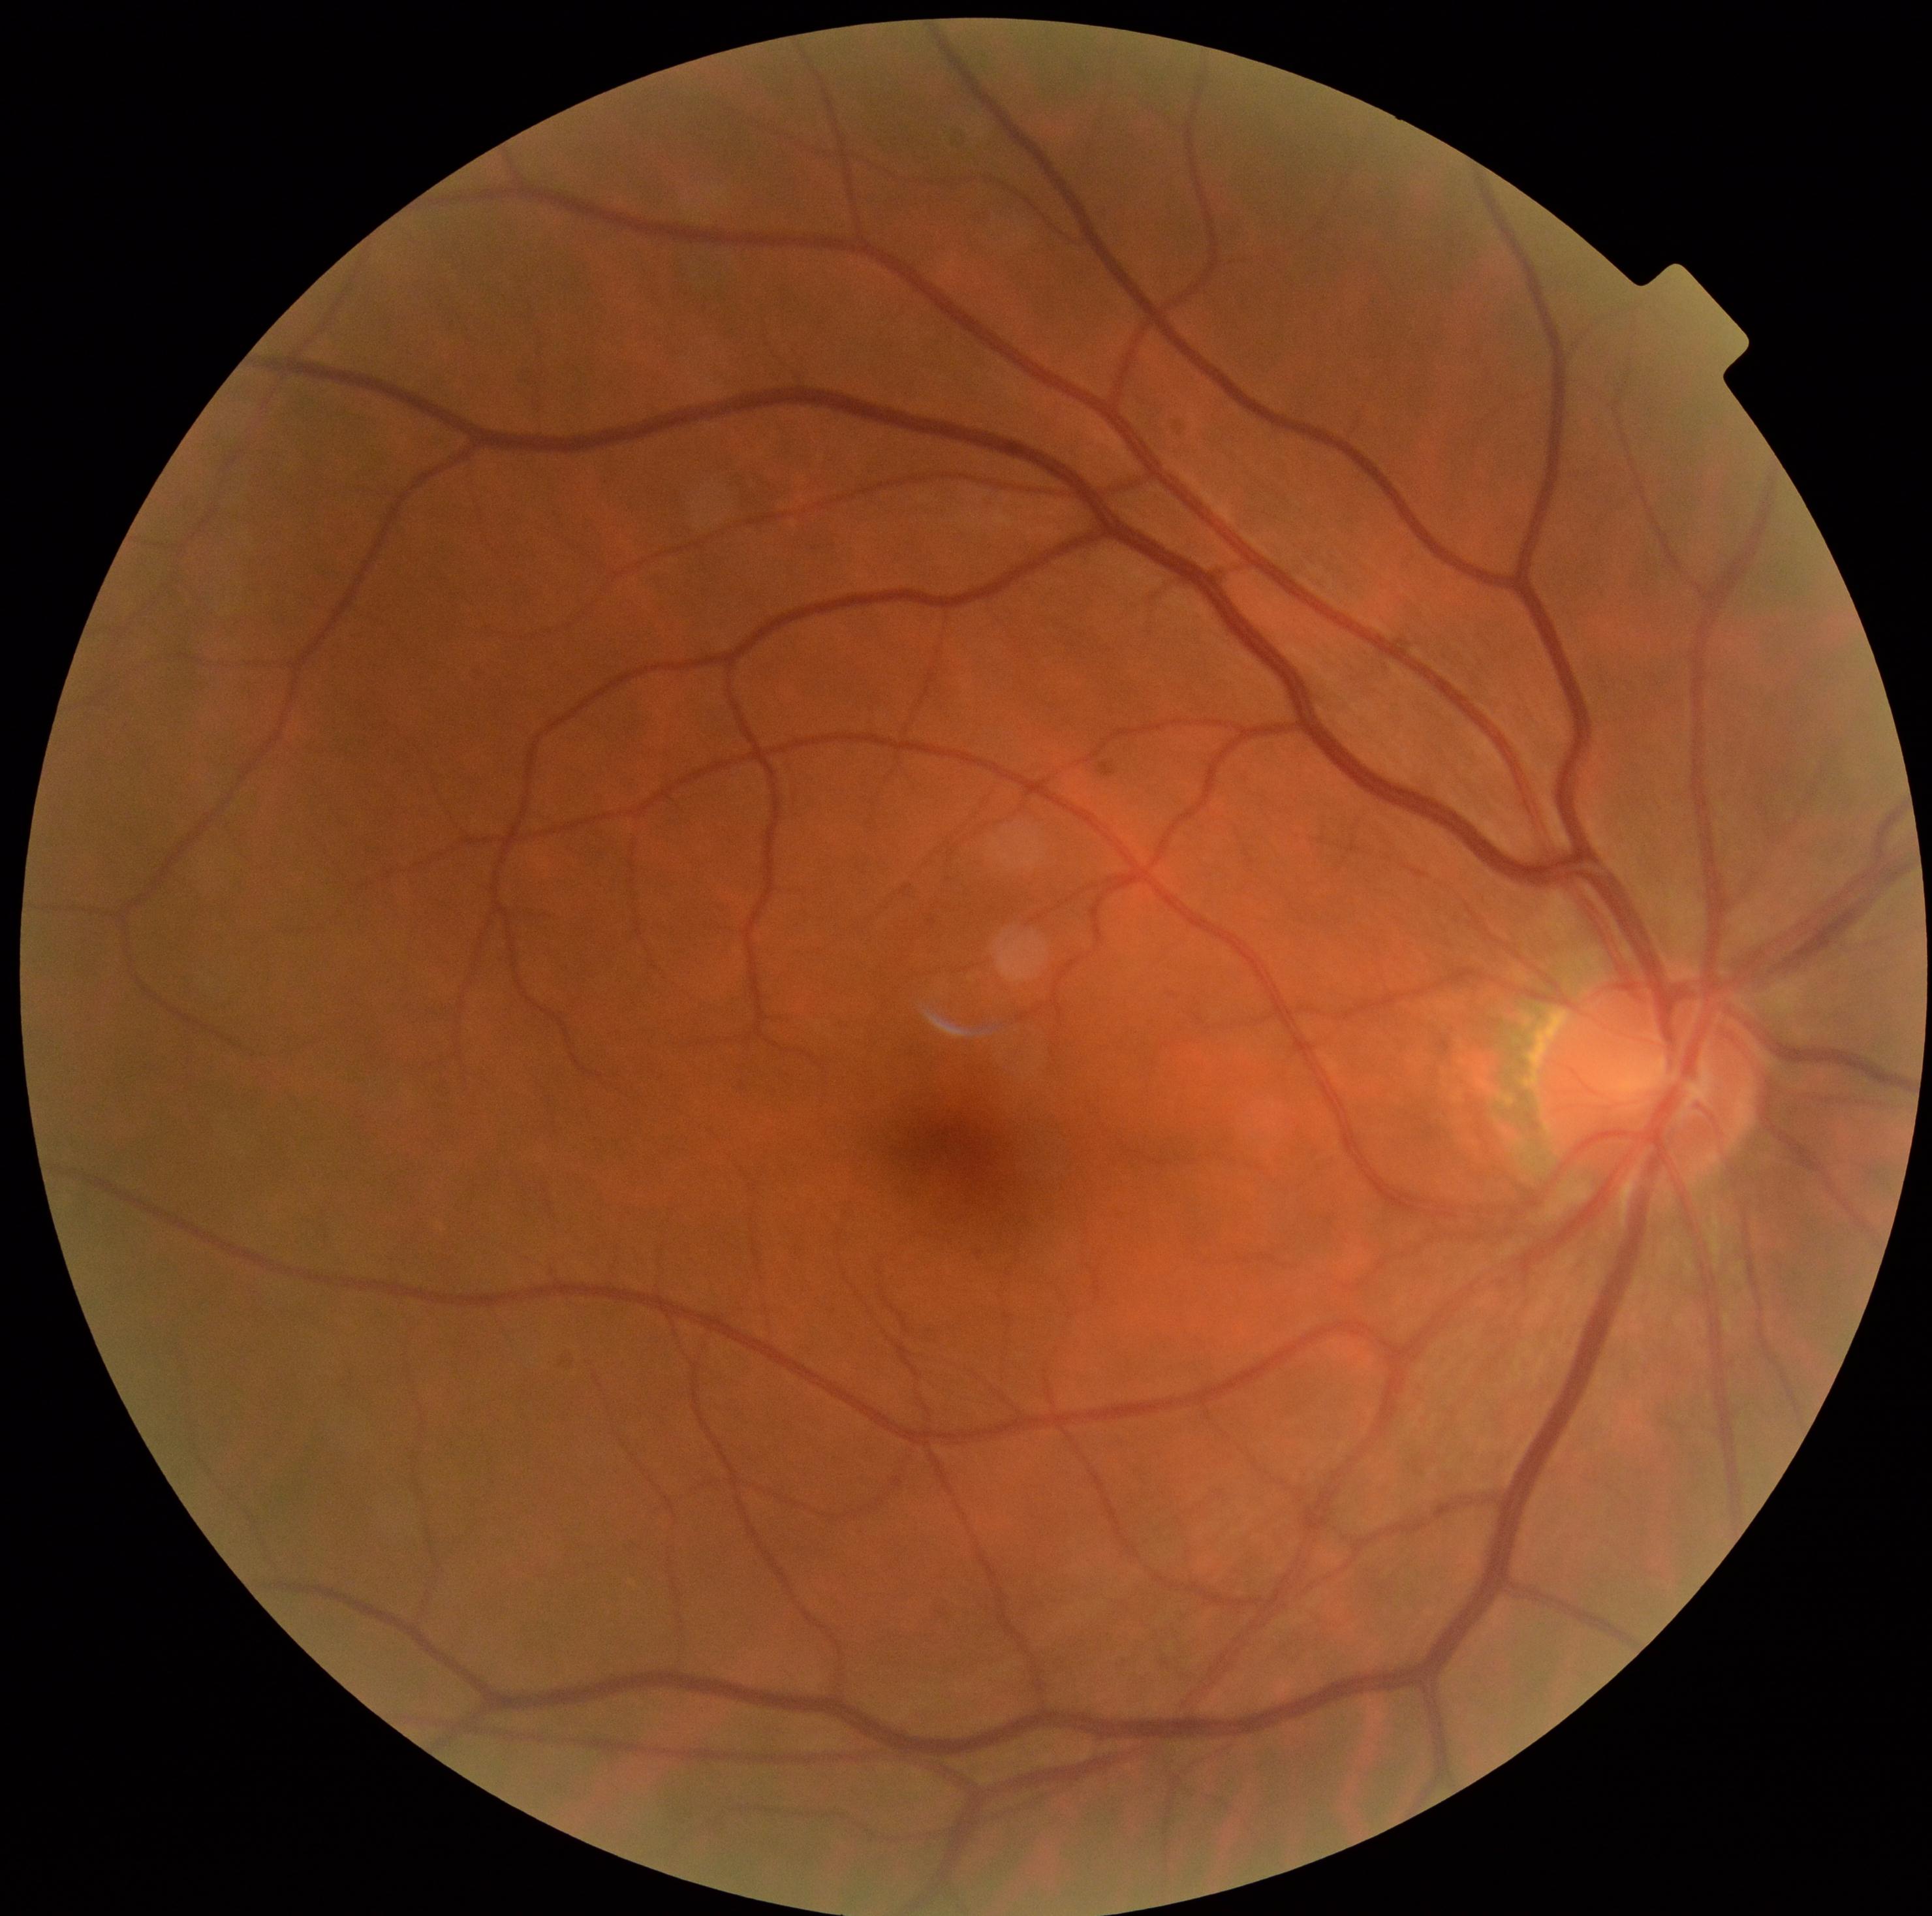
Retinopathy: 0/4.